Infant wide-field retinal image
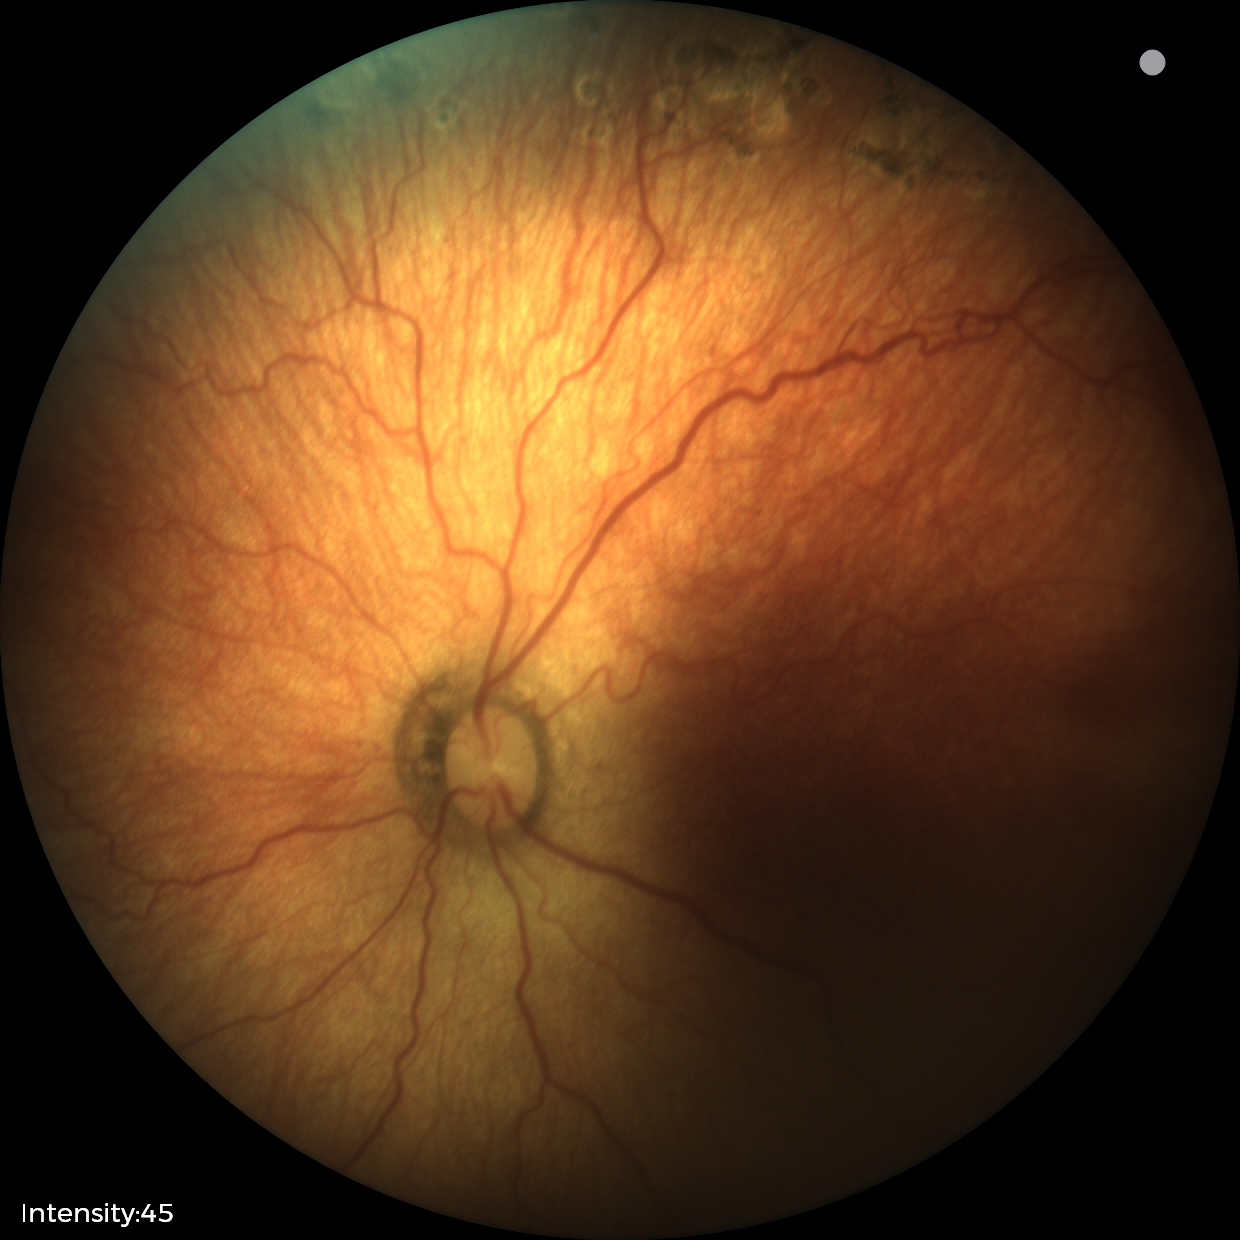
Without plus disease. Screening examination consistent with status post ROP.